45-degree field of view — 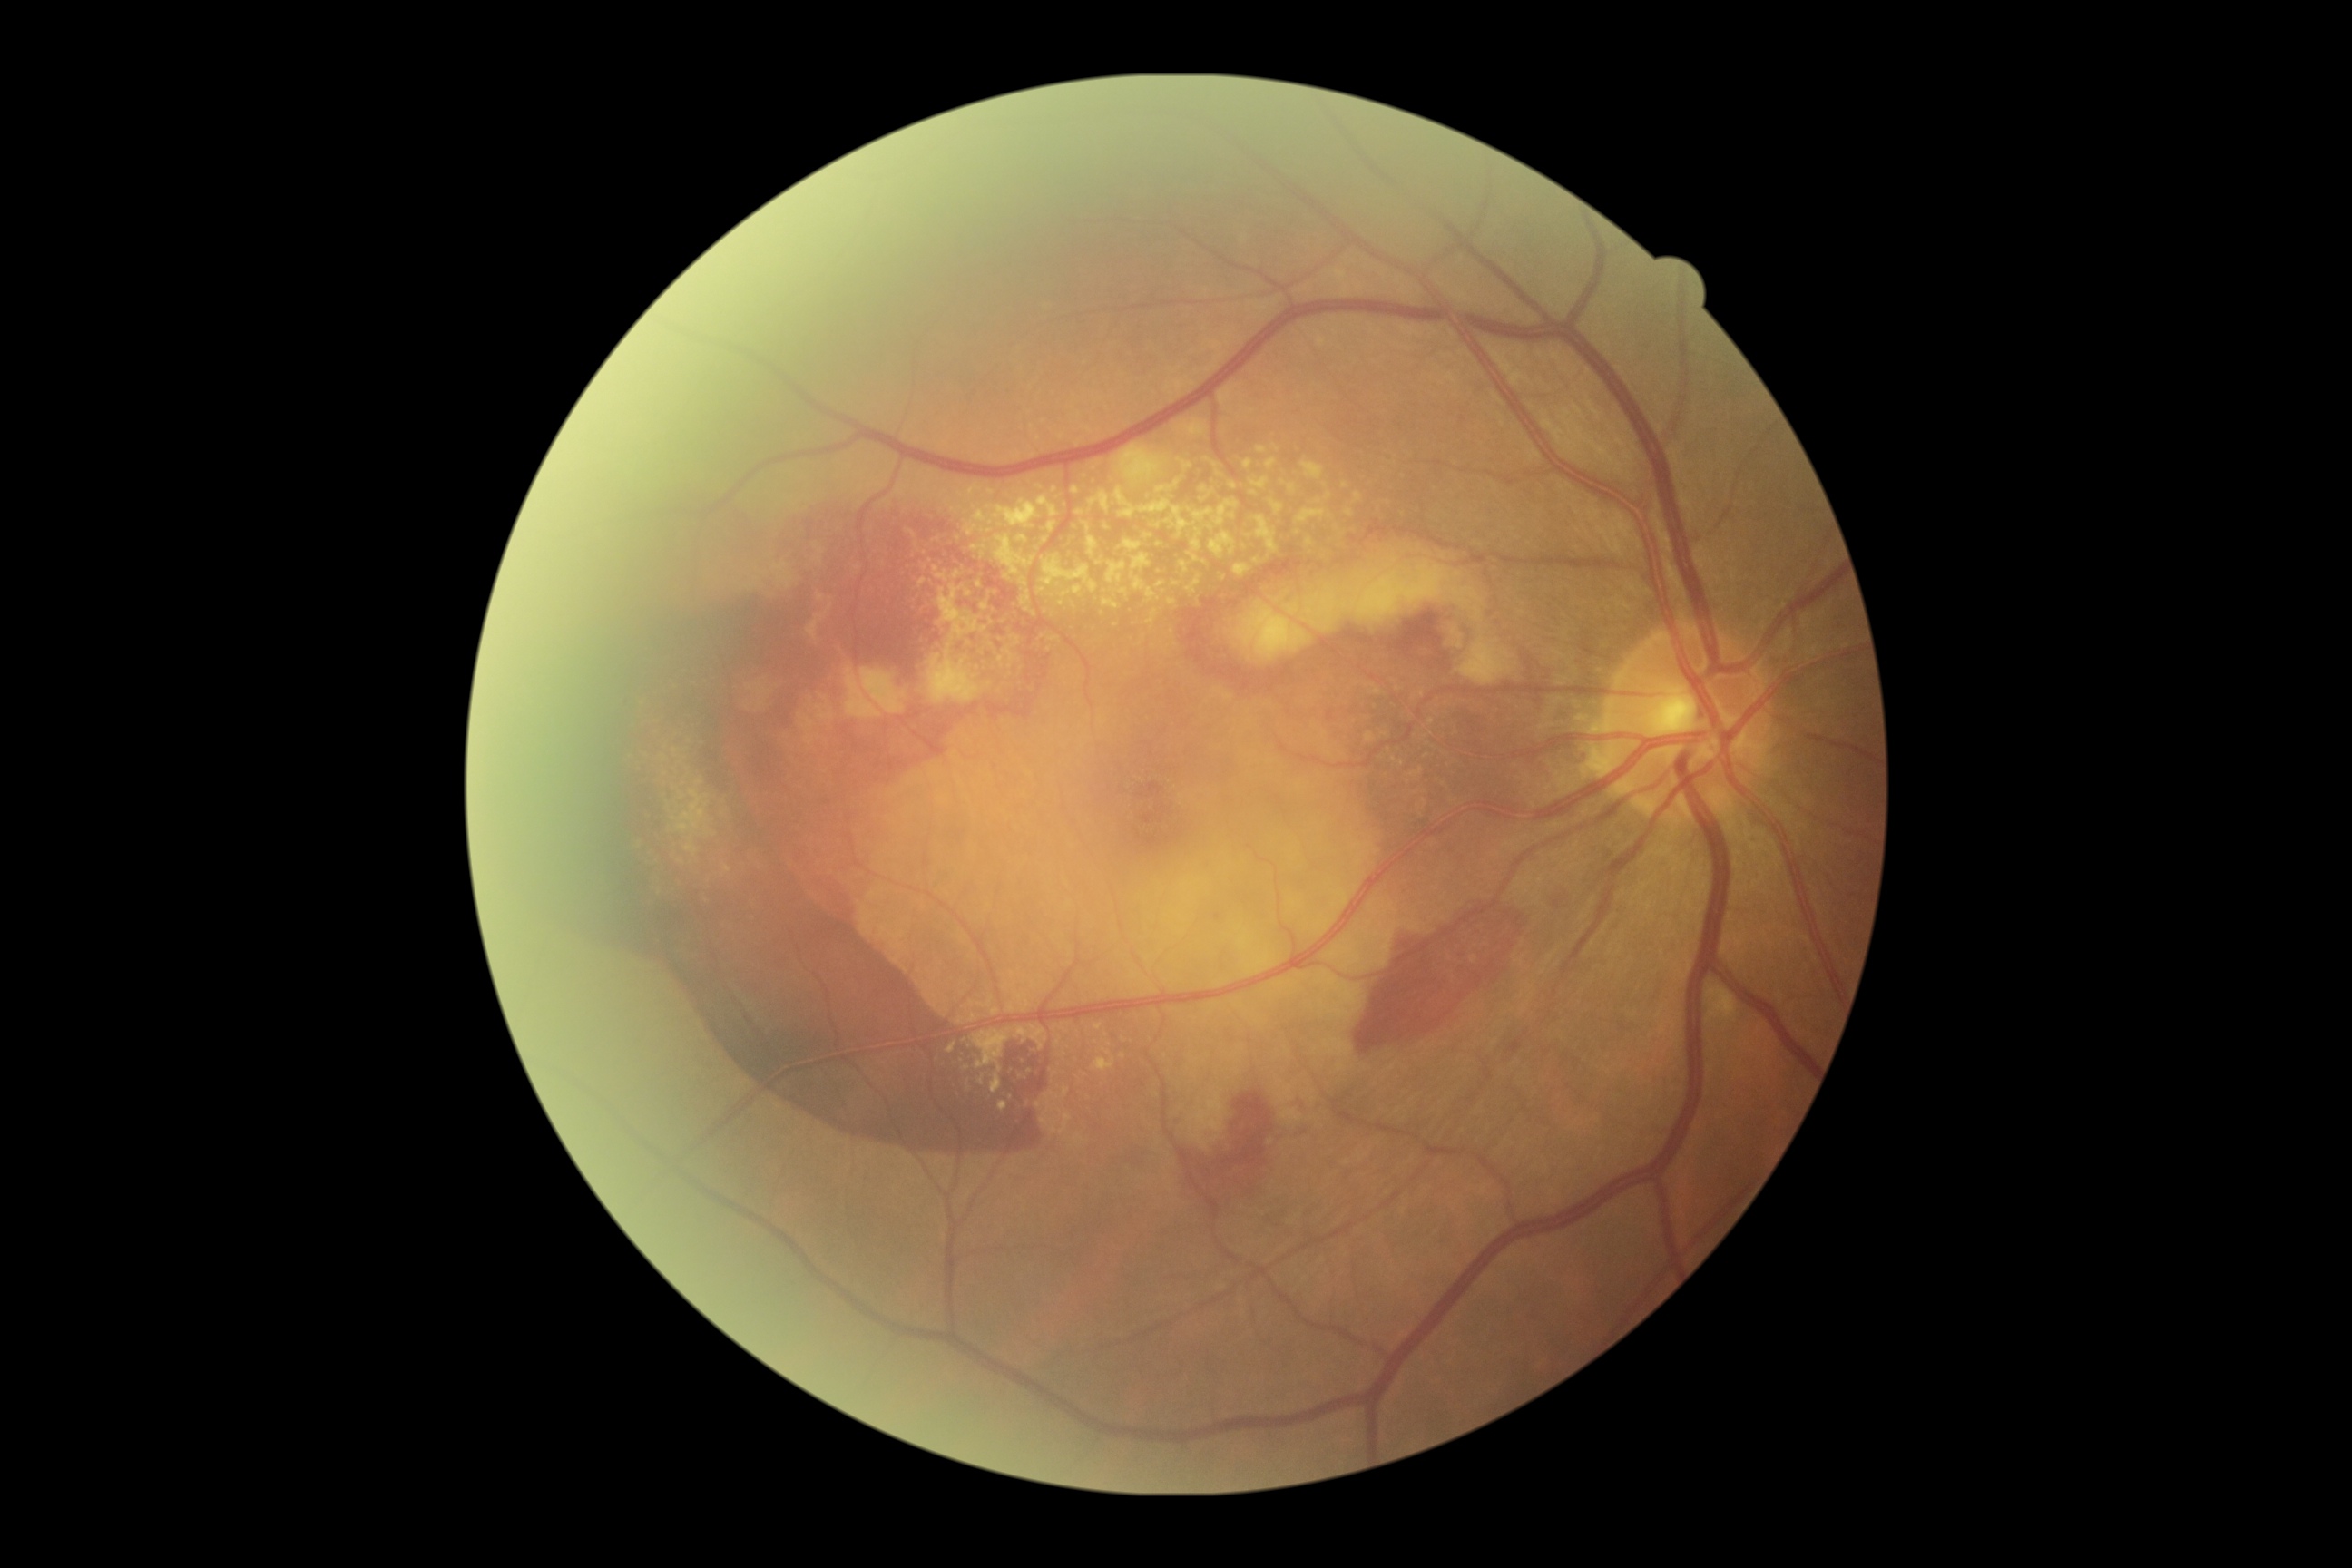 DR severity: 4/4.